Infant wide-field retinal image · 1240 by 1240 pixels:
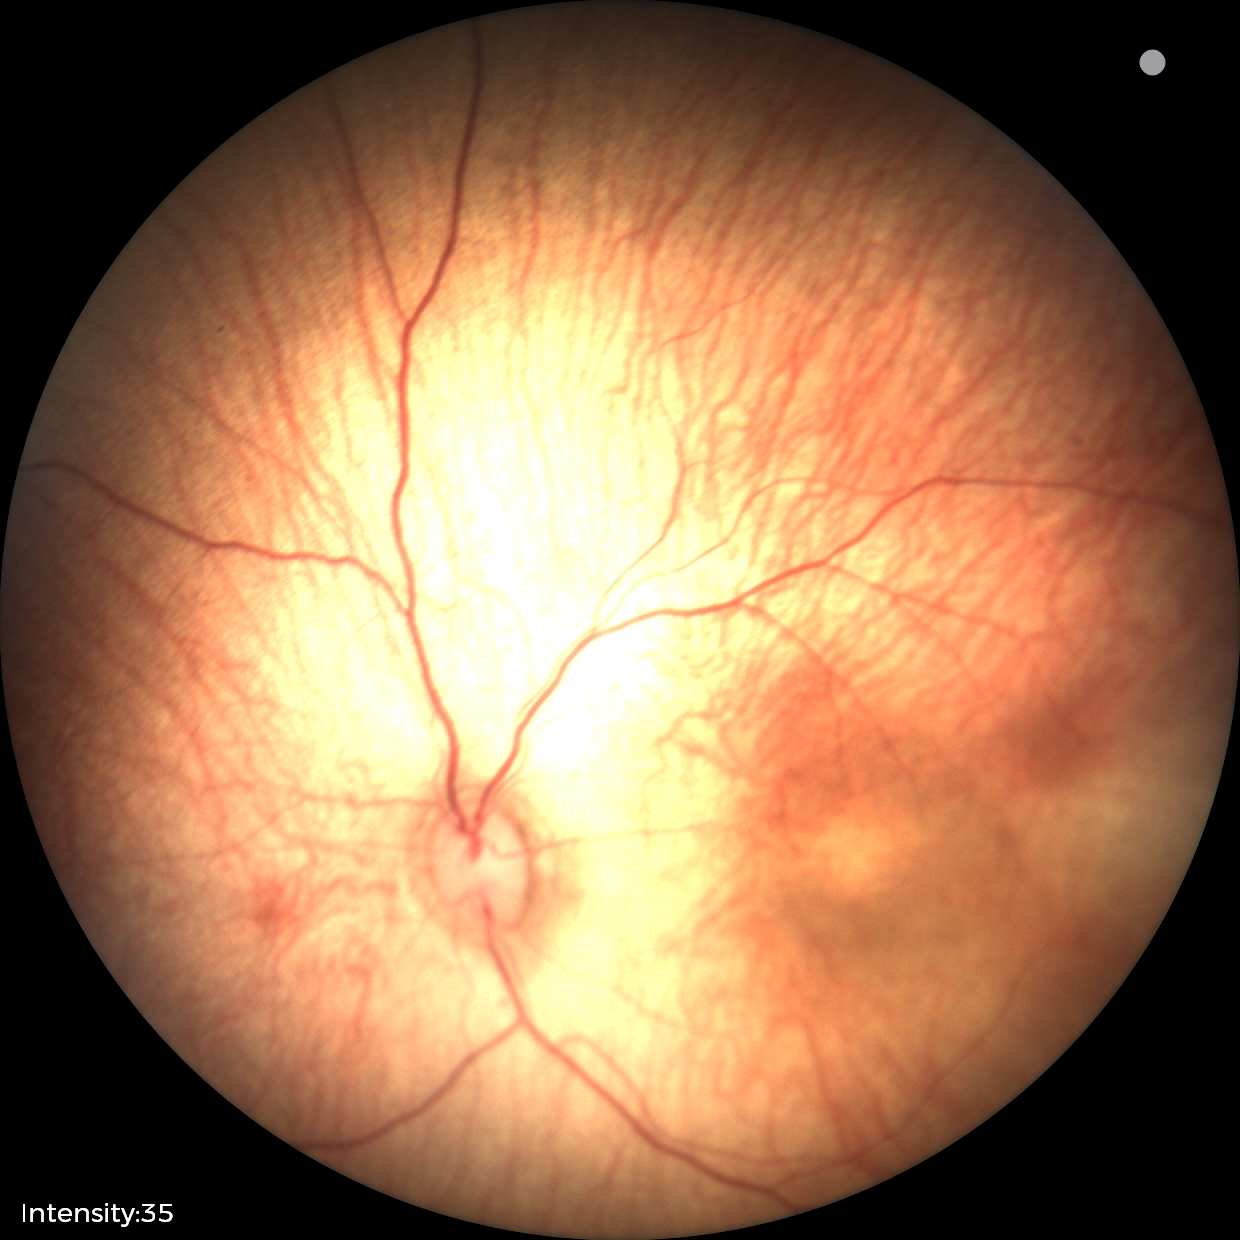
Q: What is the diagnosis from this examination?
A: status post ROP
Q: What is the plus-form classification?
A: no plus disease